Retinal fundus photograph — 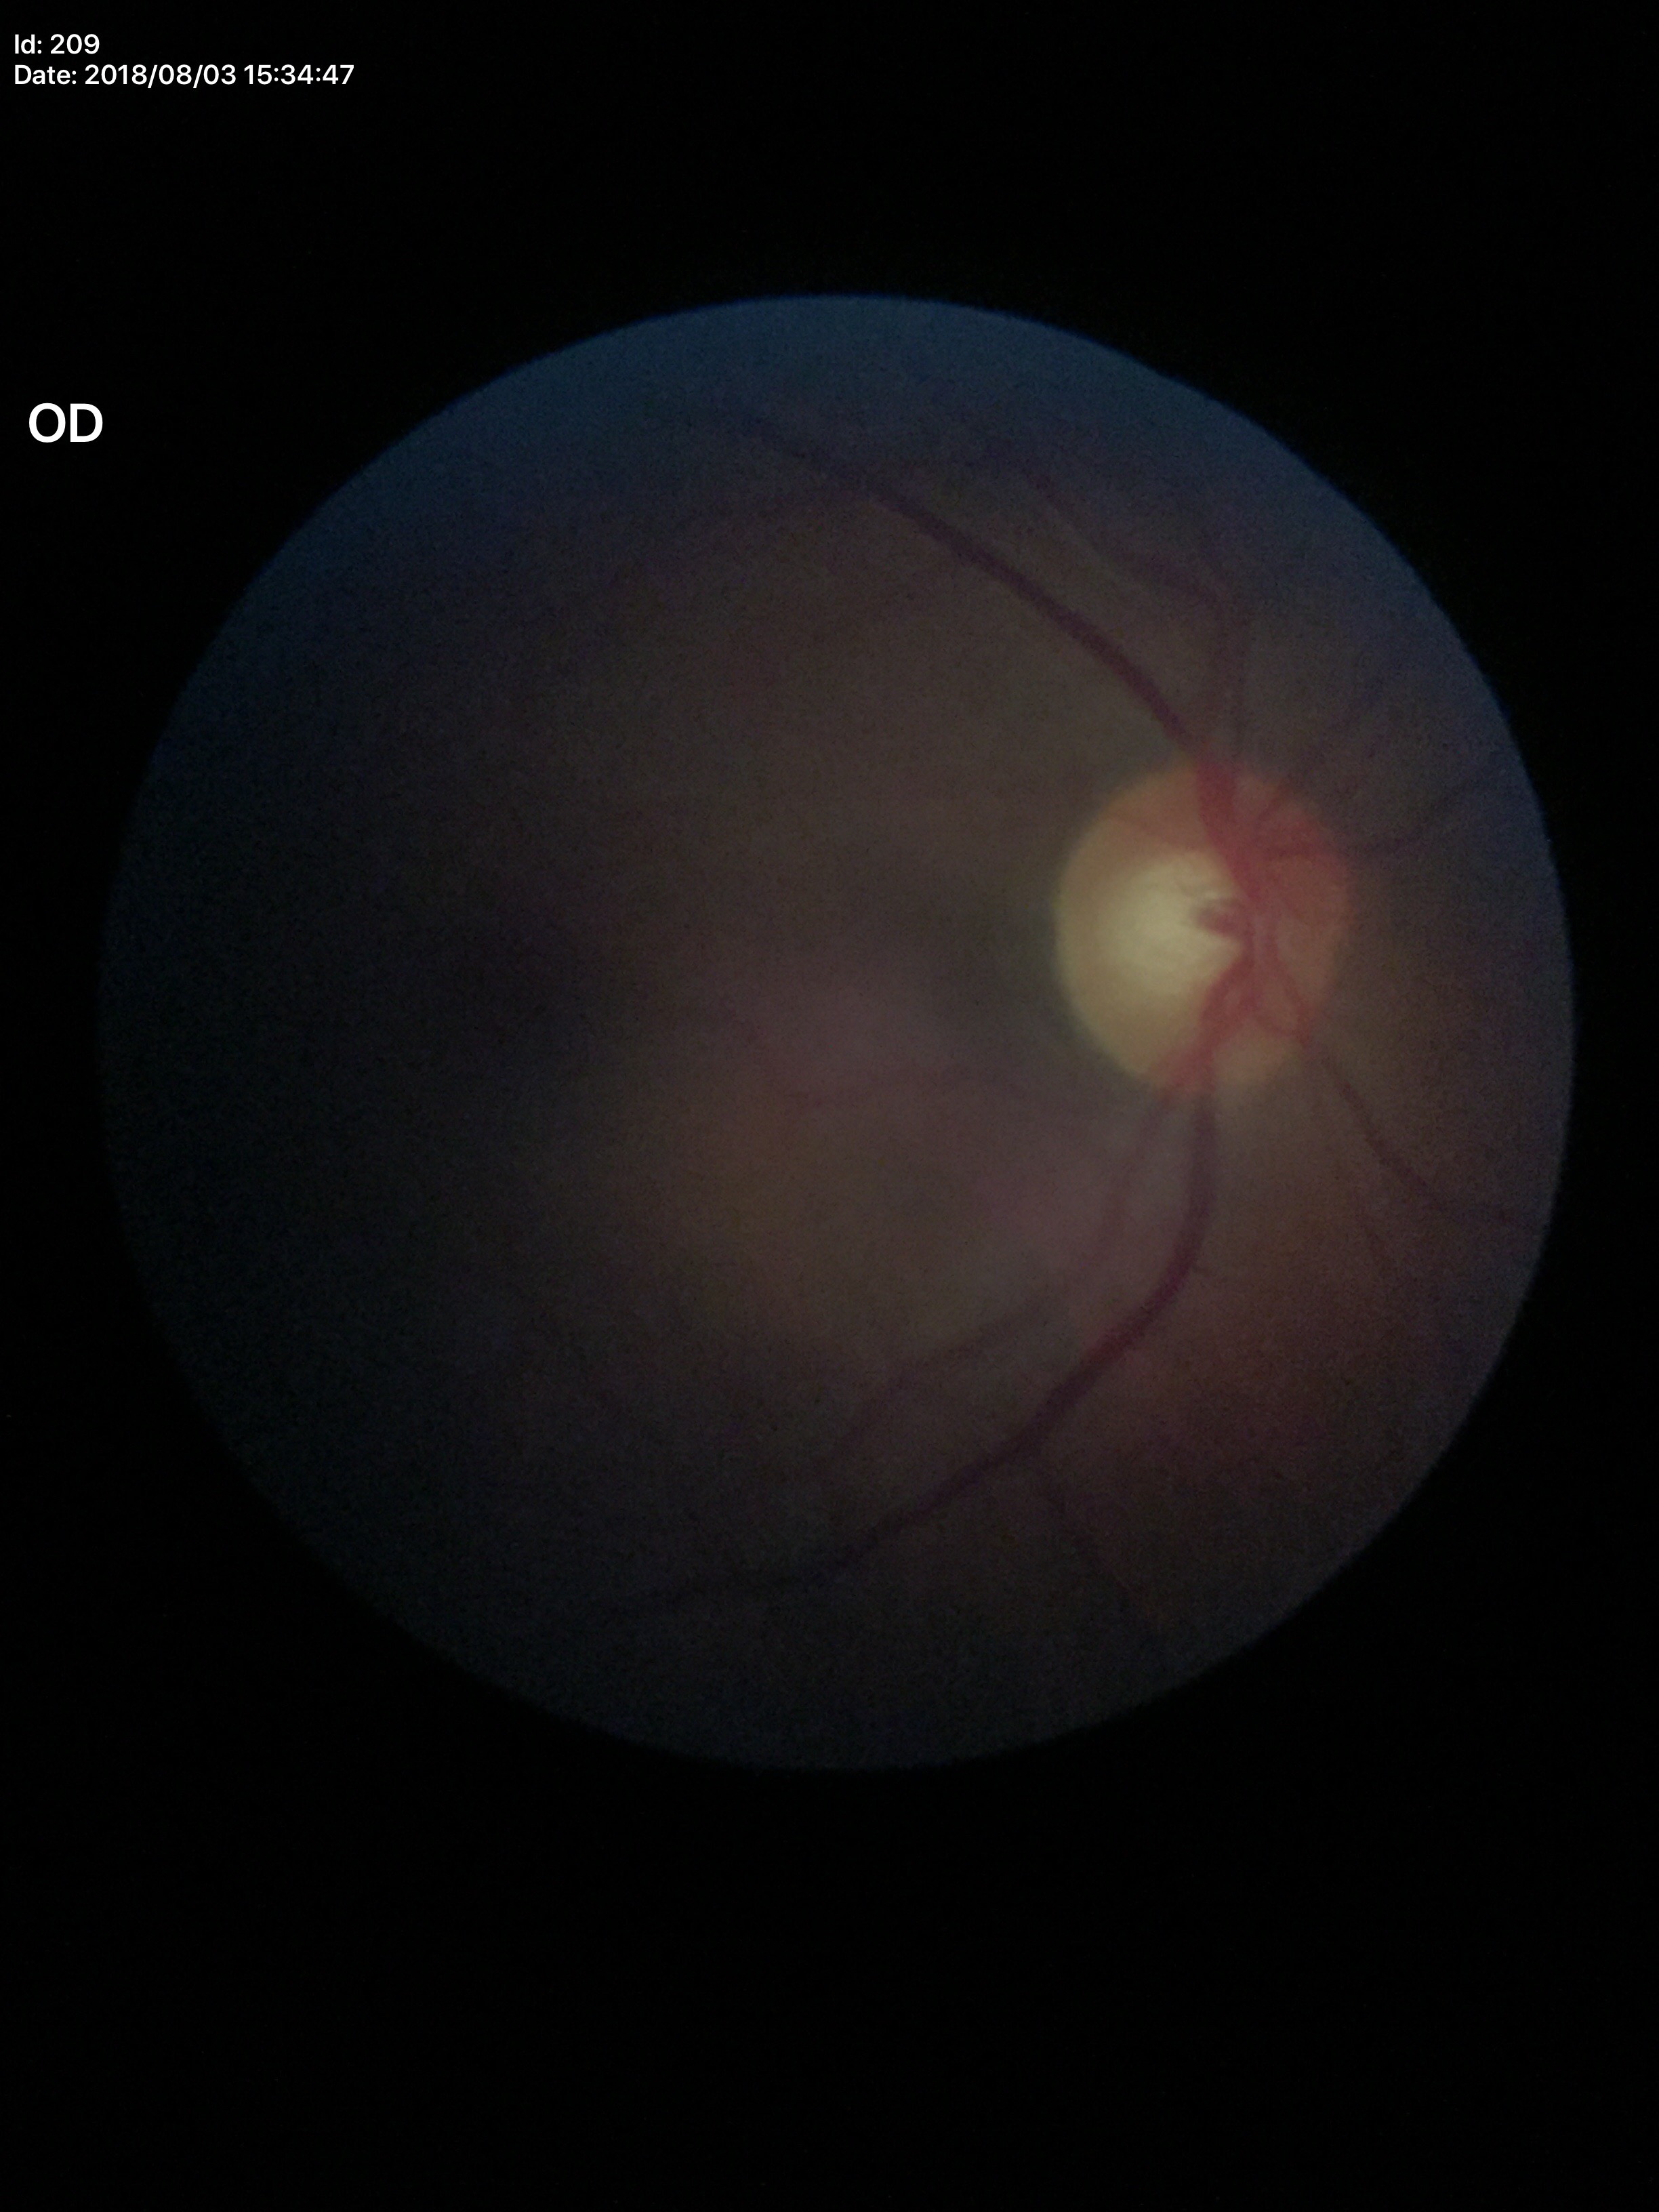

Horizontal cup-to-disc ratio: 0.60. Glaucoma decision: no suspicious findings. Vertical C/D ratio: 0.57.